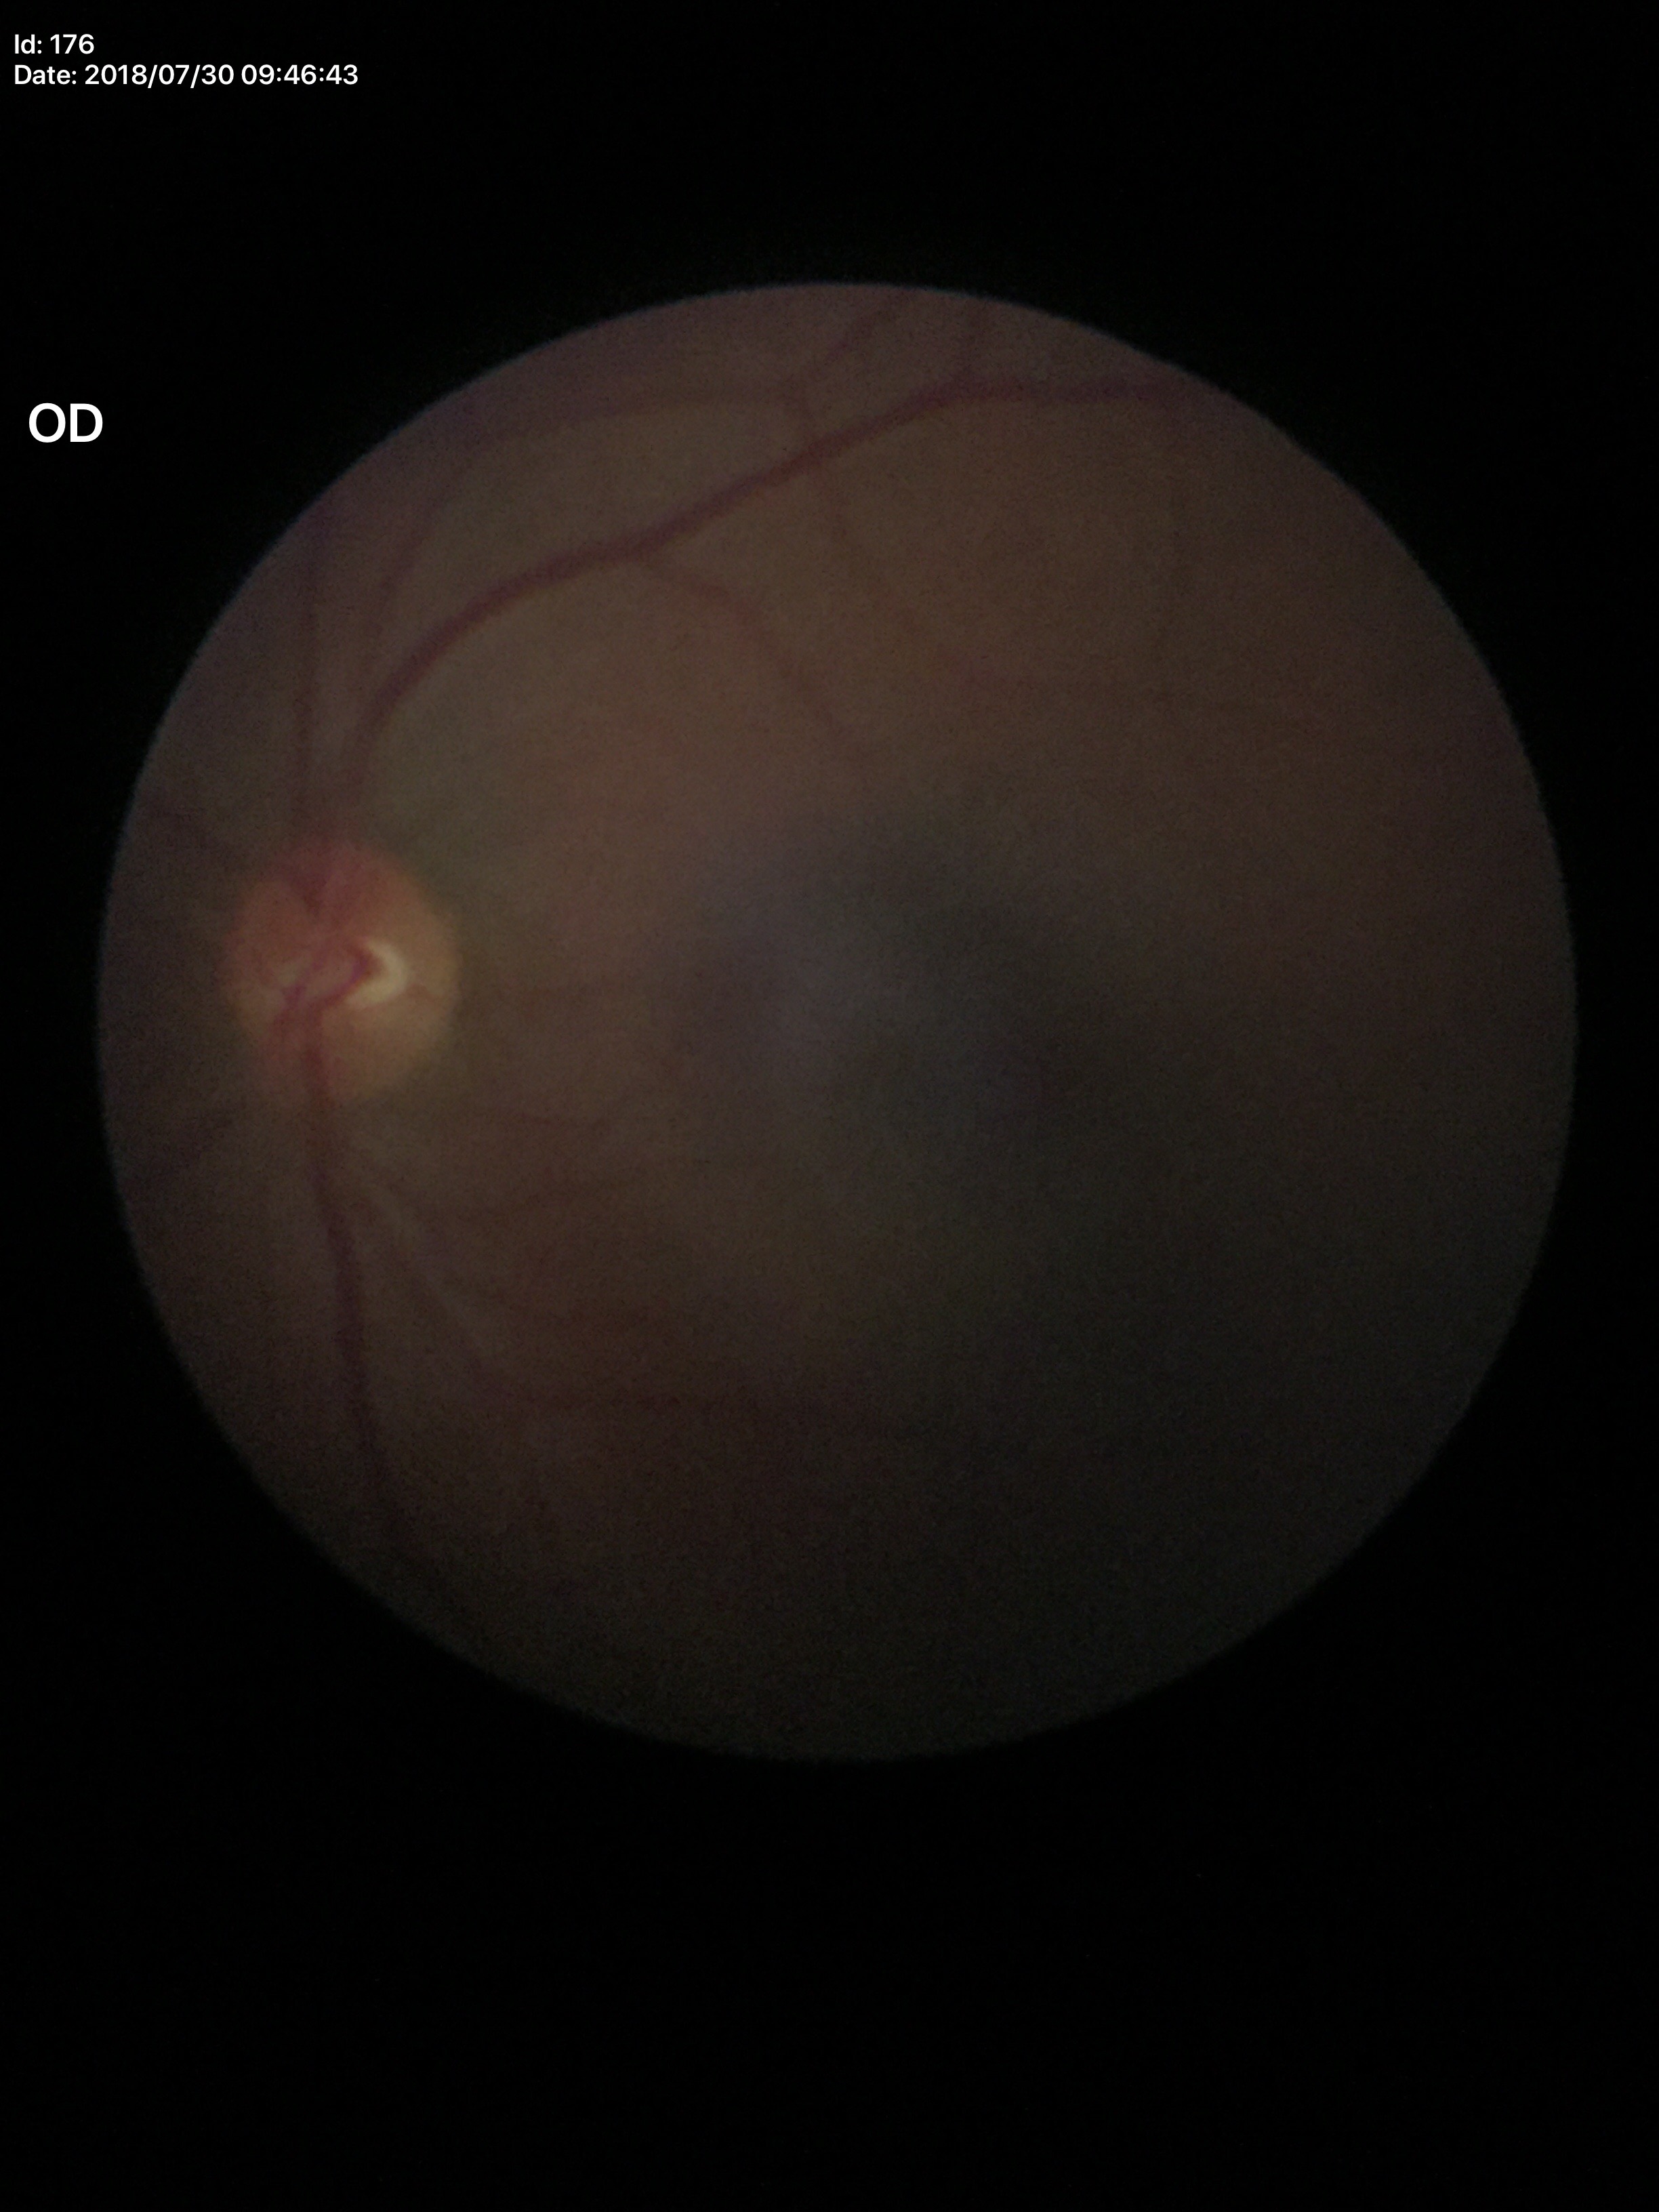
* area cup-to-disc ratio — 0.20
* Glaucoma screening — not suspect
* vertical CDR — 0.35